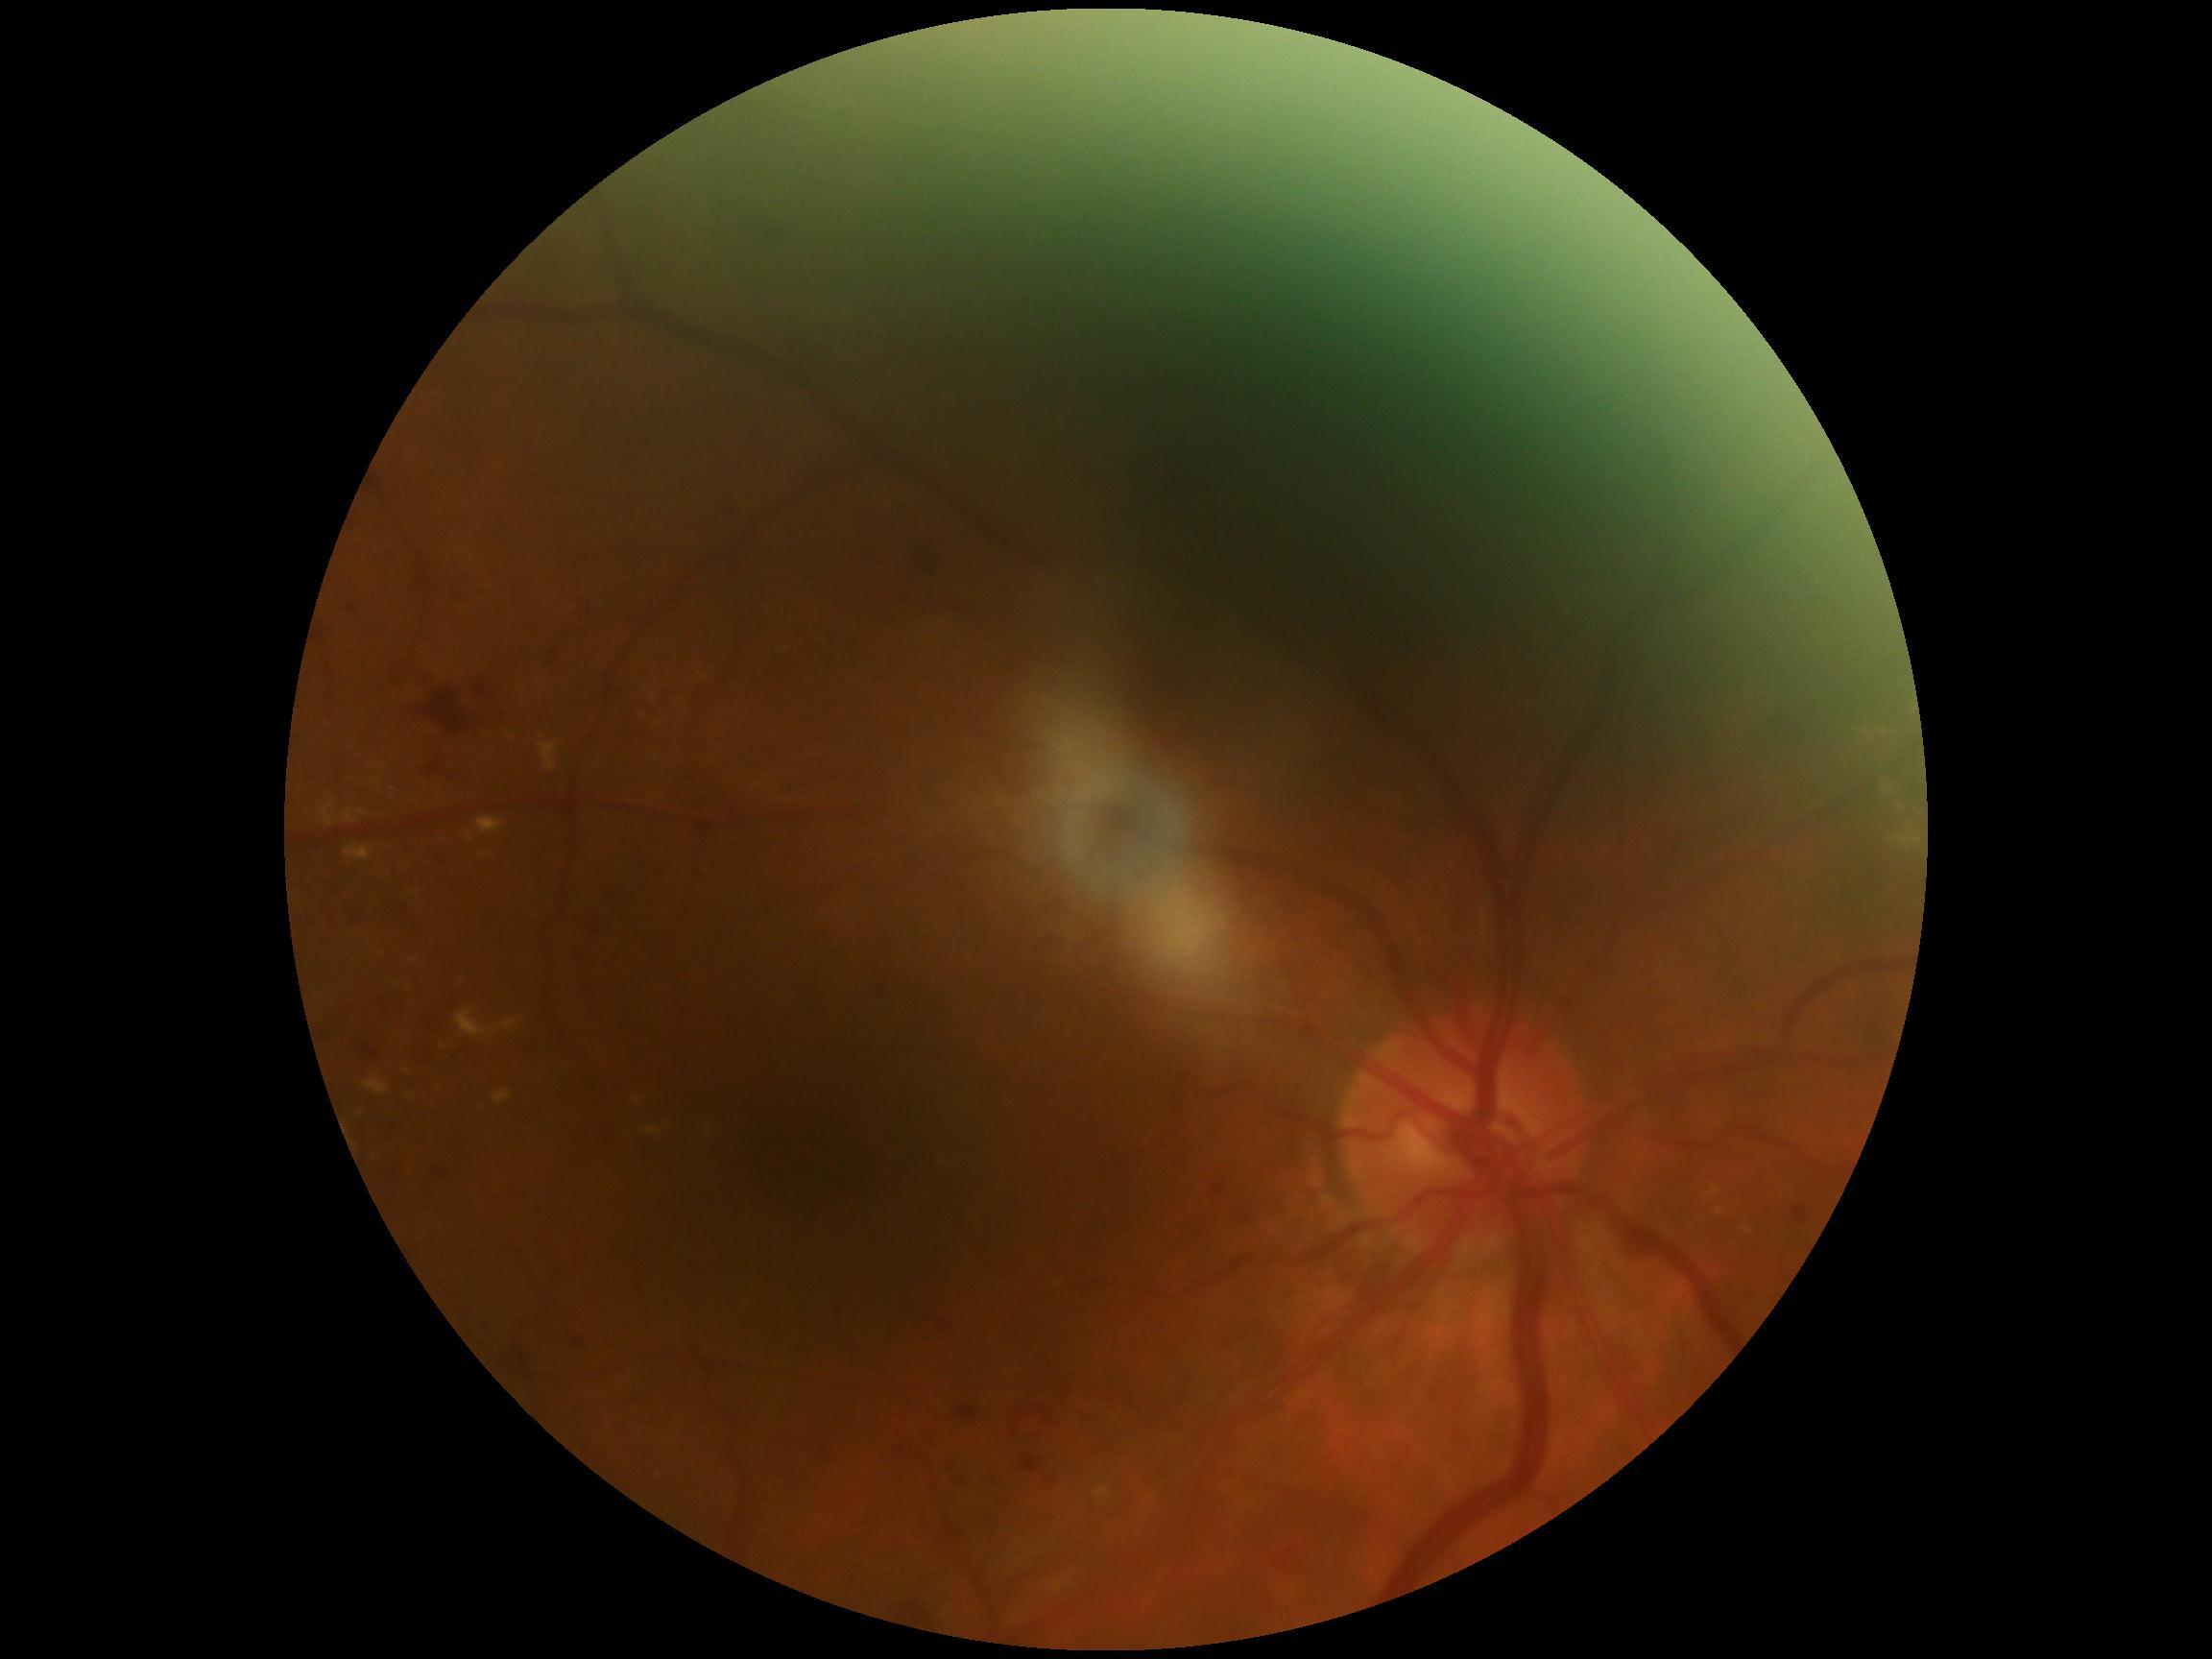

Diabetic retinopathy (DR) is grade 2 (moderate NPDR).